FOV: 45 degrees · NIDEK AFC-230 · nonmydriatic · 848 x 848 pixels · CFP
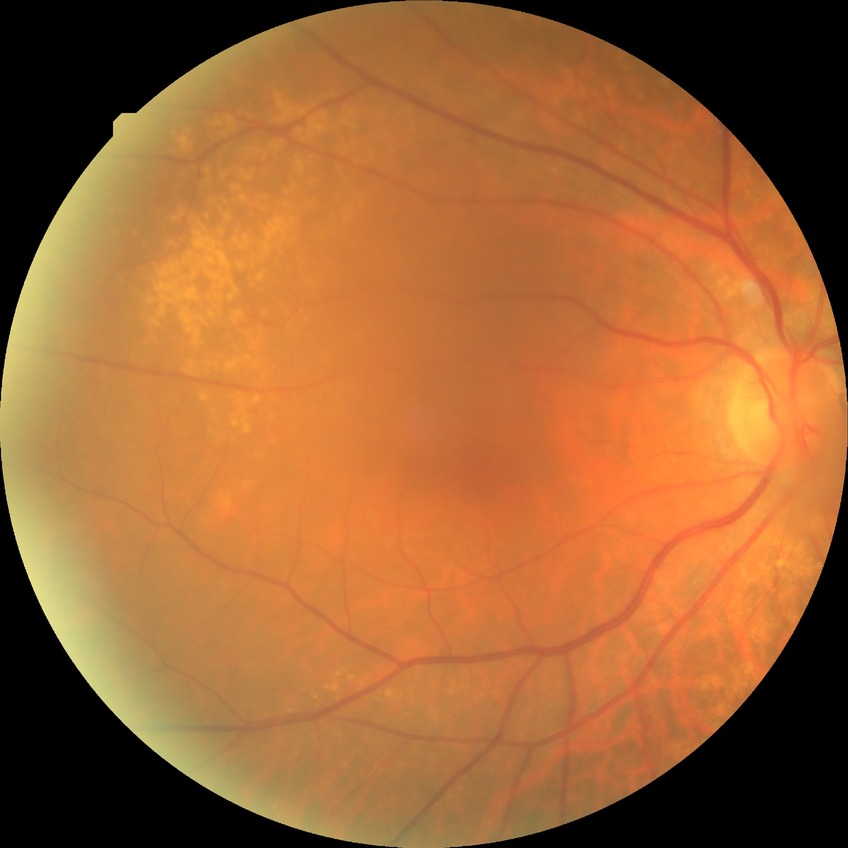 Retinopathy stage: no diabetic retinopathy.